Fundus photo.
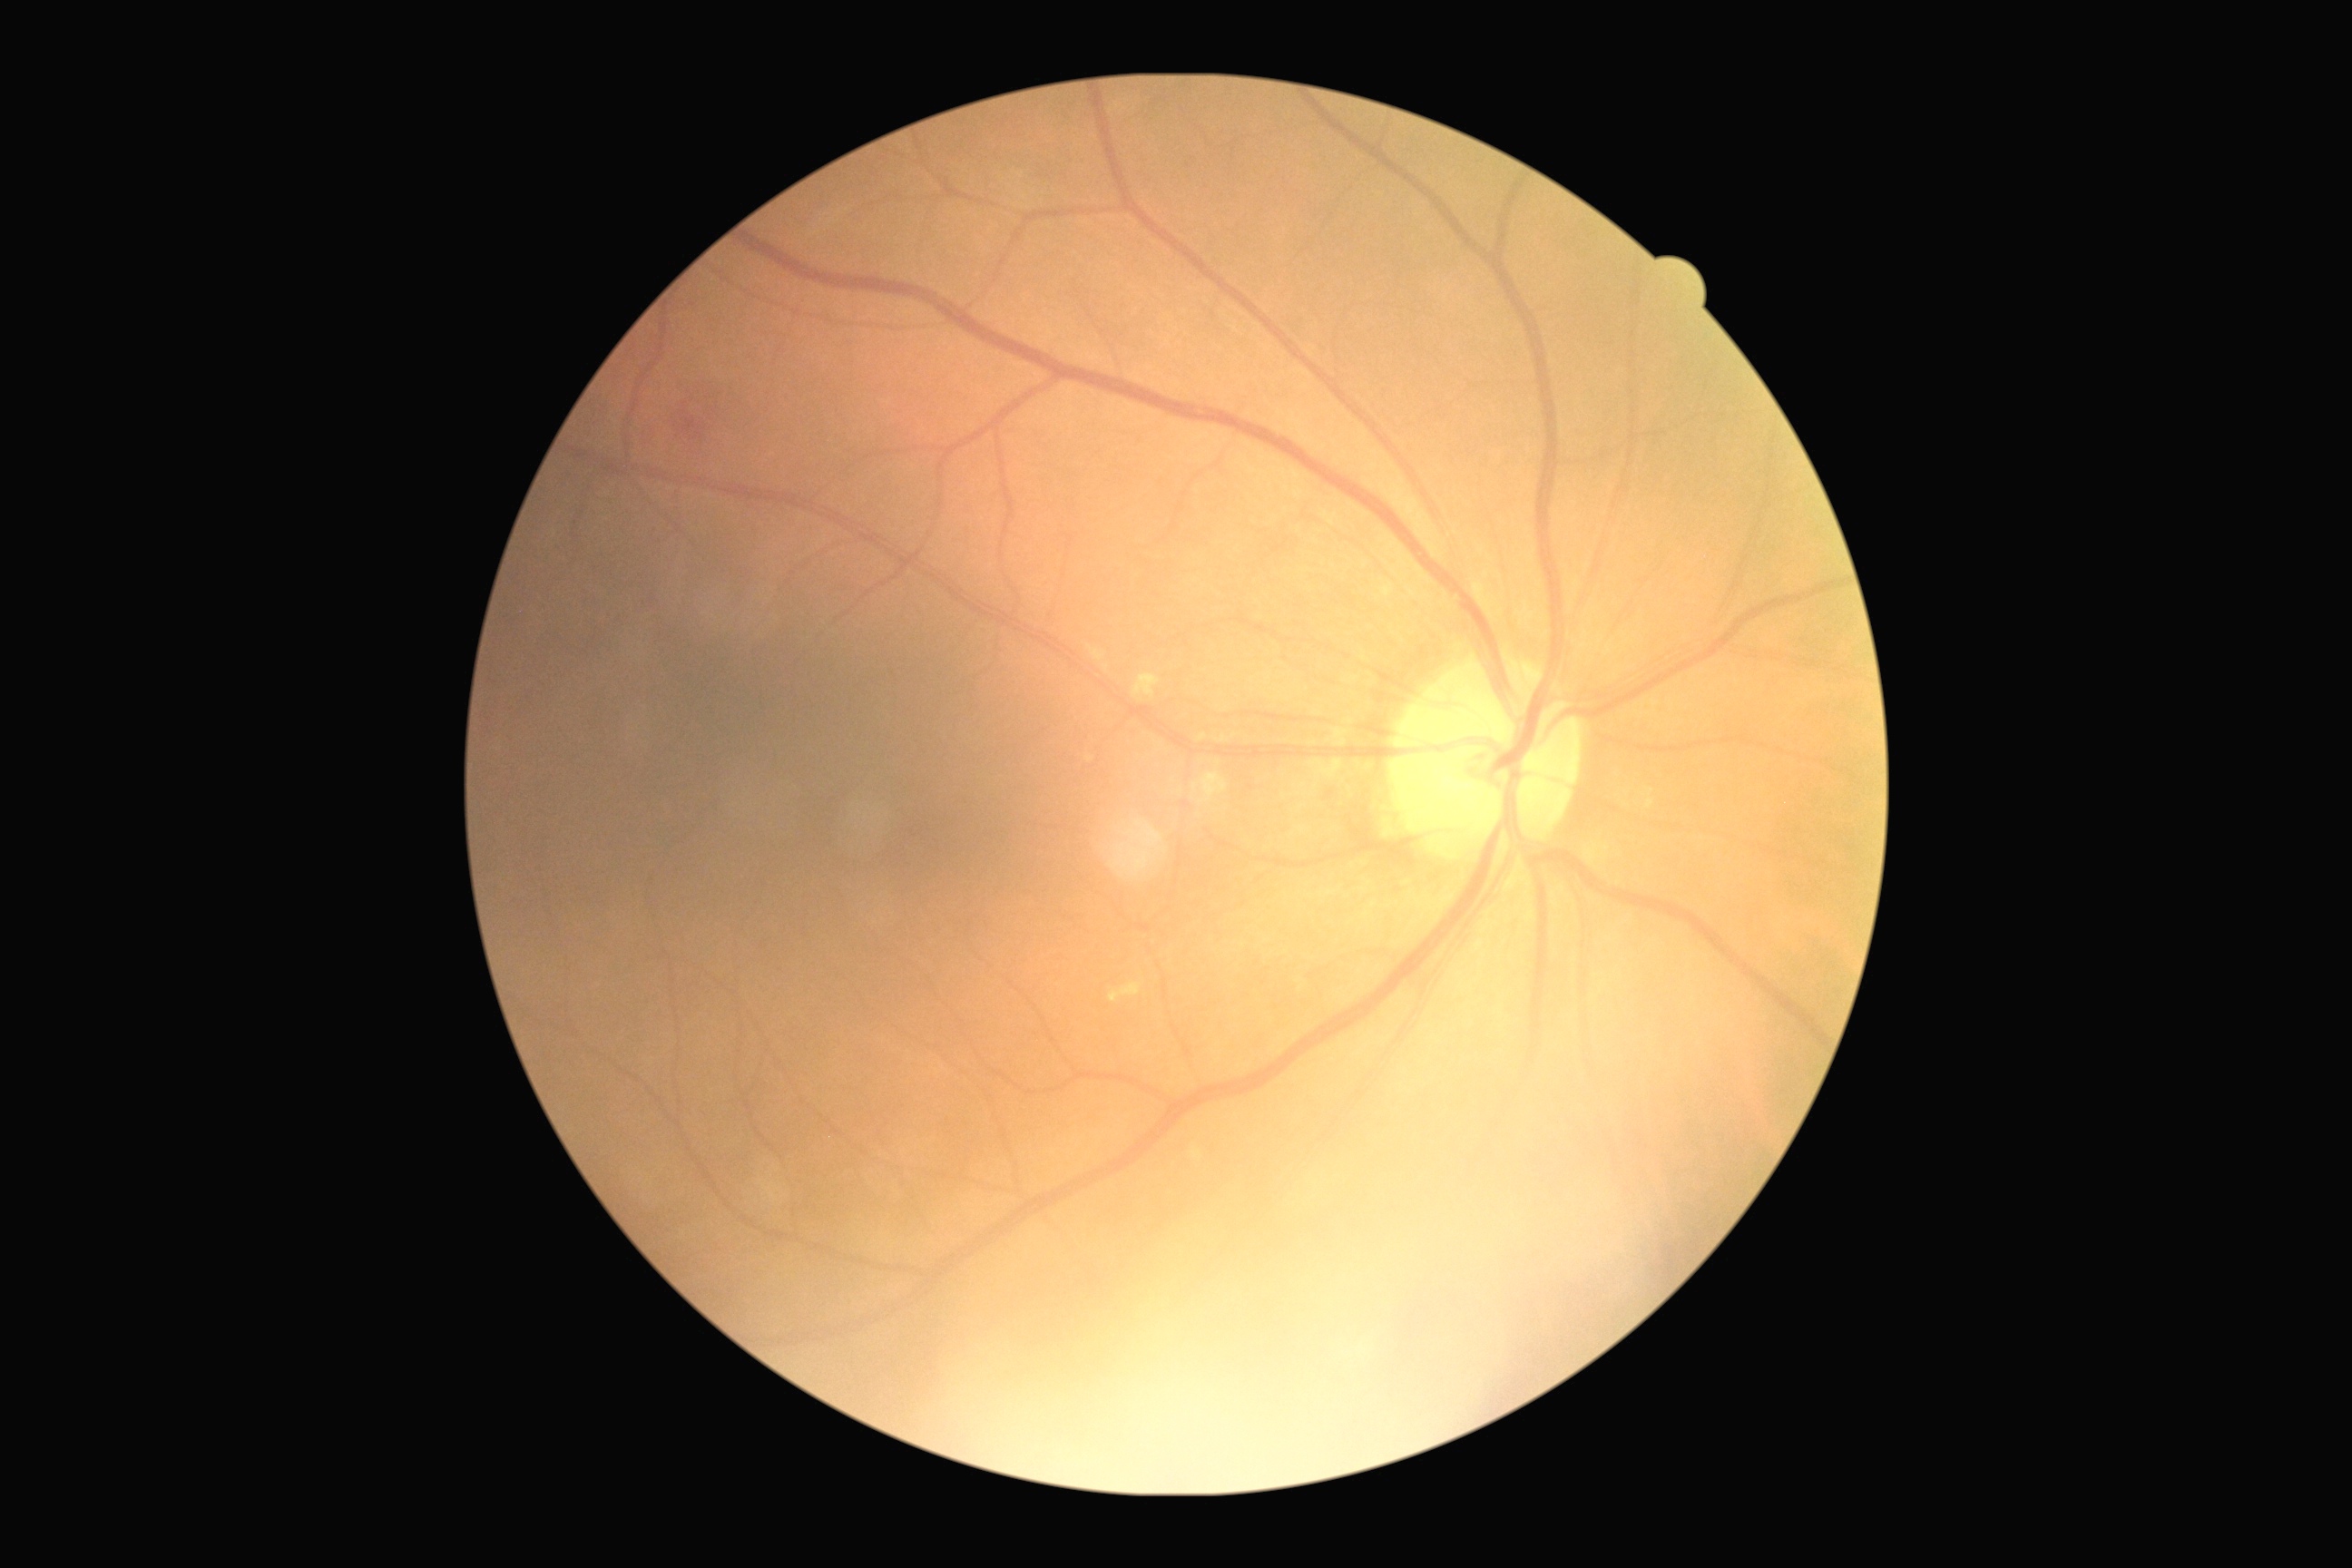 Retinopathy: grade 2 (moderate NPDR).